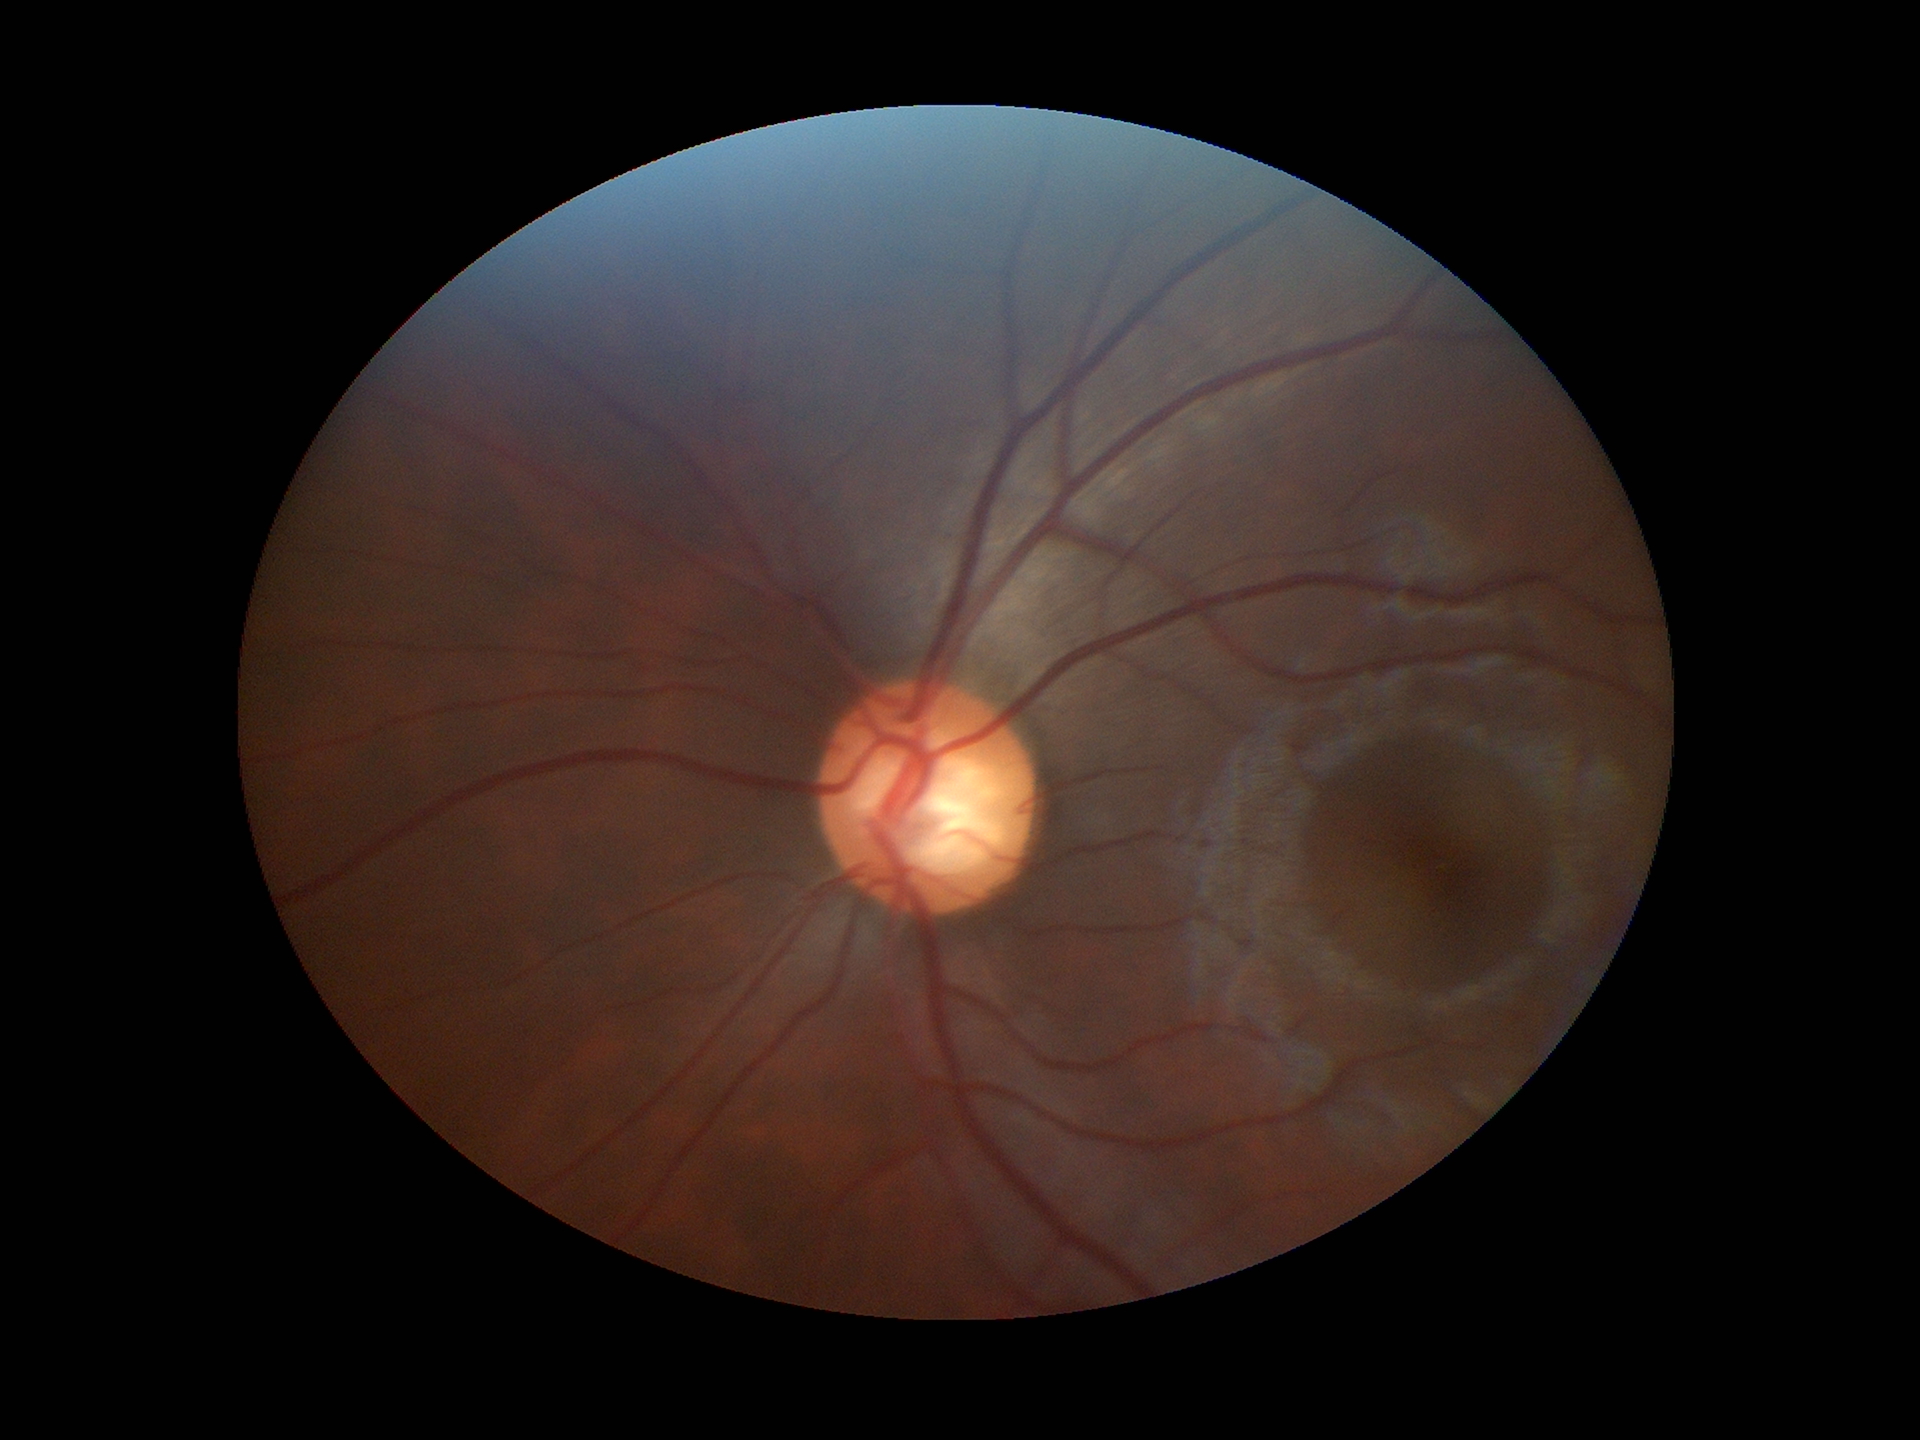 Concerning for glaucoma. Vertical cup-disc ratio of 0.62. Horizontal cup-to-disc ratio: 0.65.